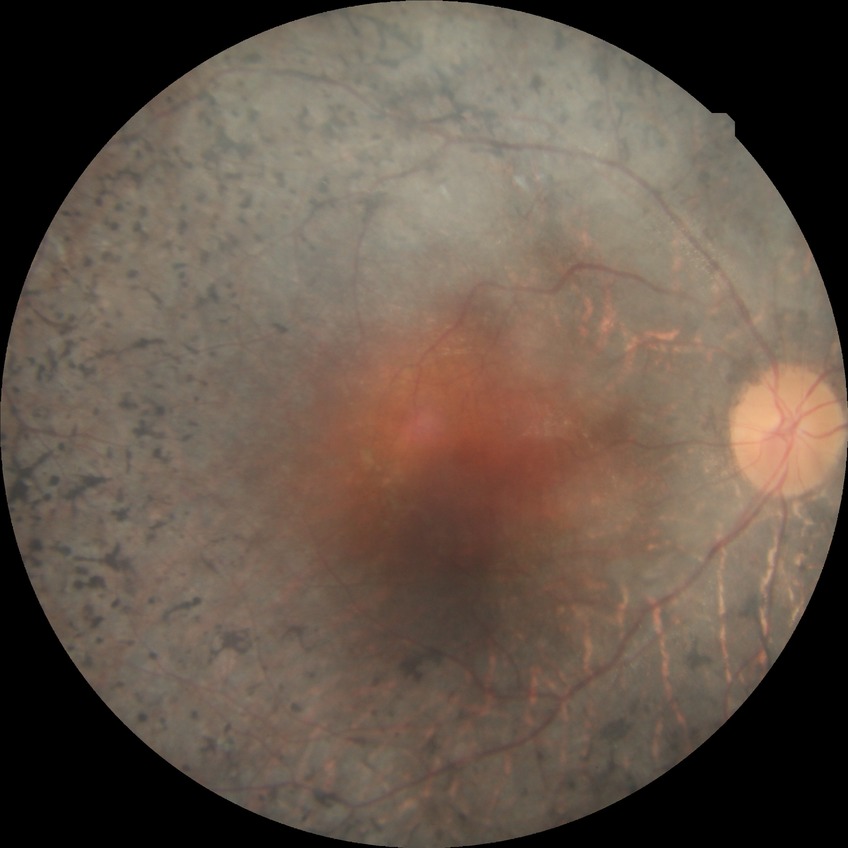

- Davis grading: no diabetic retinopathy